Color fundus image
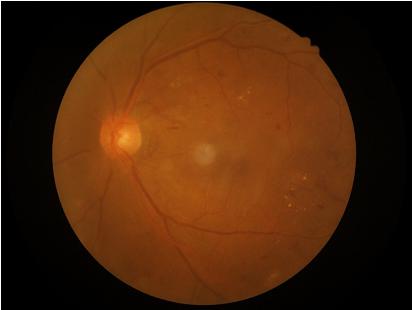
  overall_quality: satisfactory
  clarity: good
  illumination: even
  contrast: good